Non-mydriatic fundus camera · image size 240x240 — 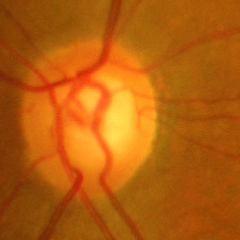 Severe glaucomatous damage.
Diagnostic criteria: near-total cupping of the optic nerve head, with or without severe visual field loss within the central 10 degrees of fixation.